Color fundus image, 1932 x 1916 pixels.
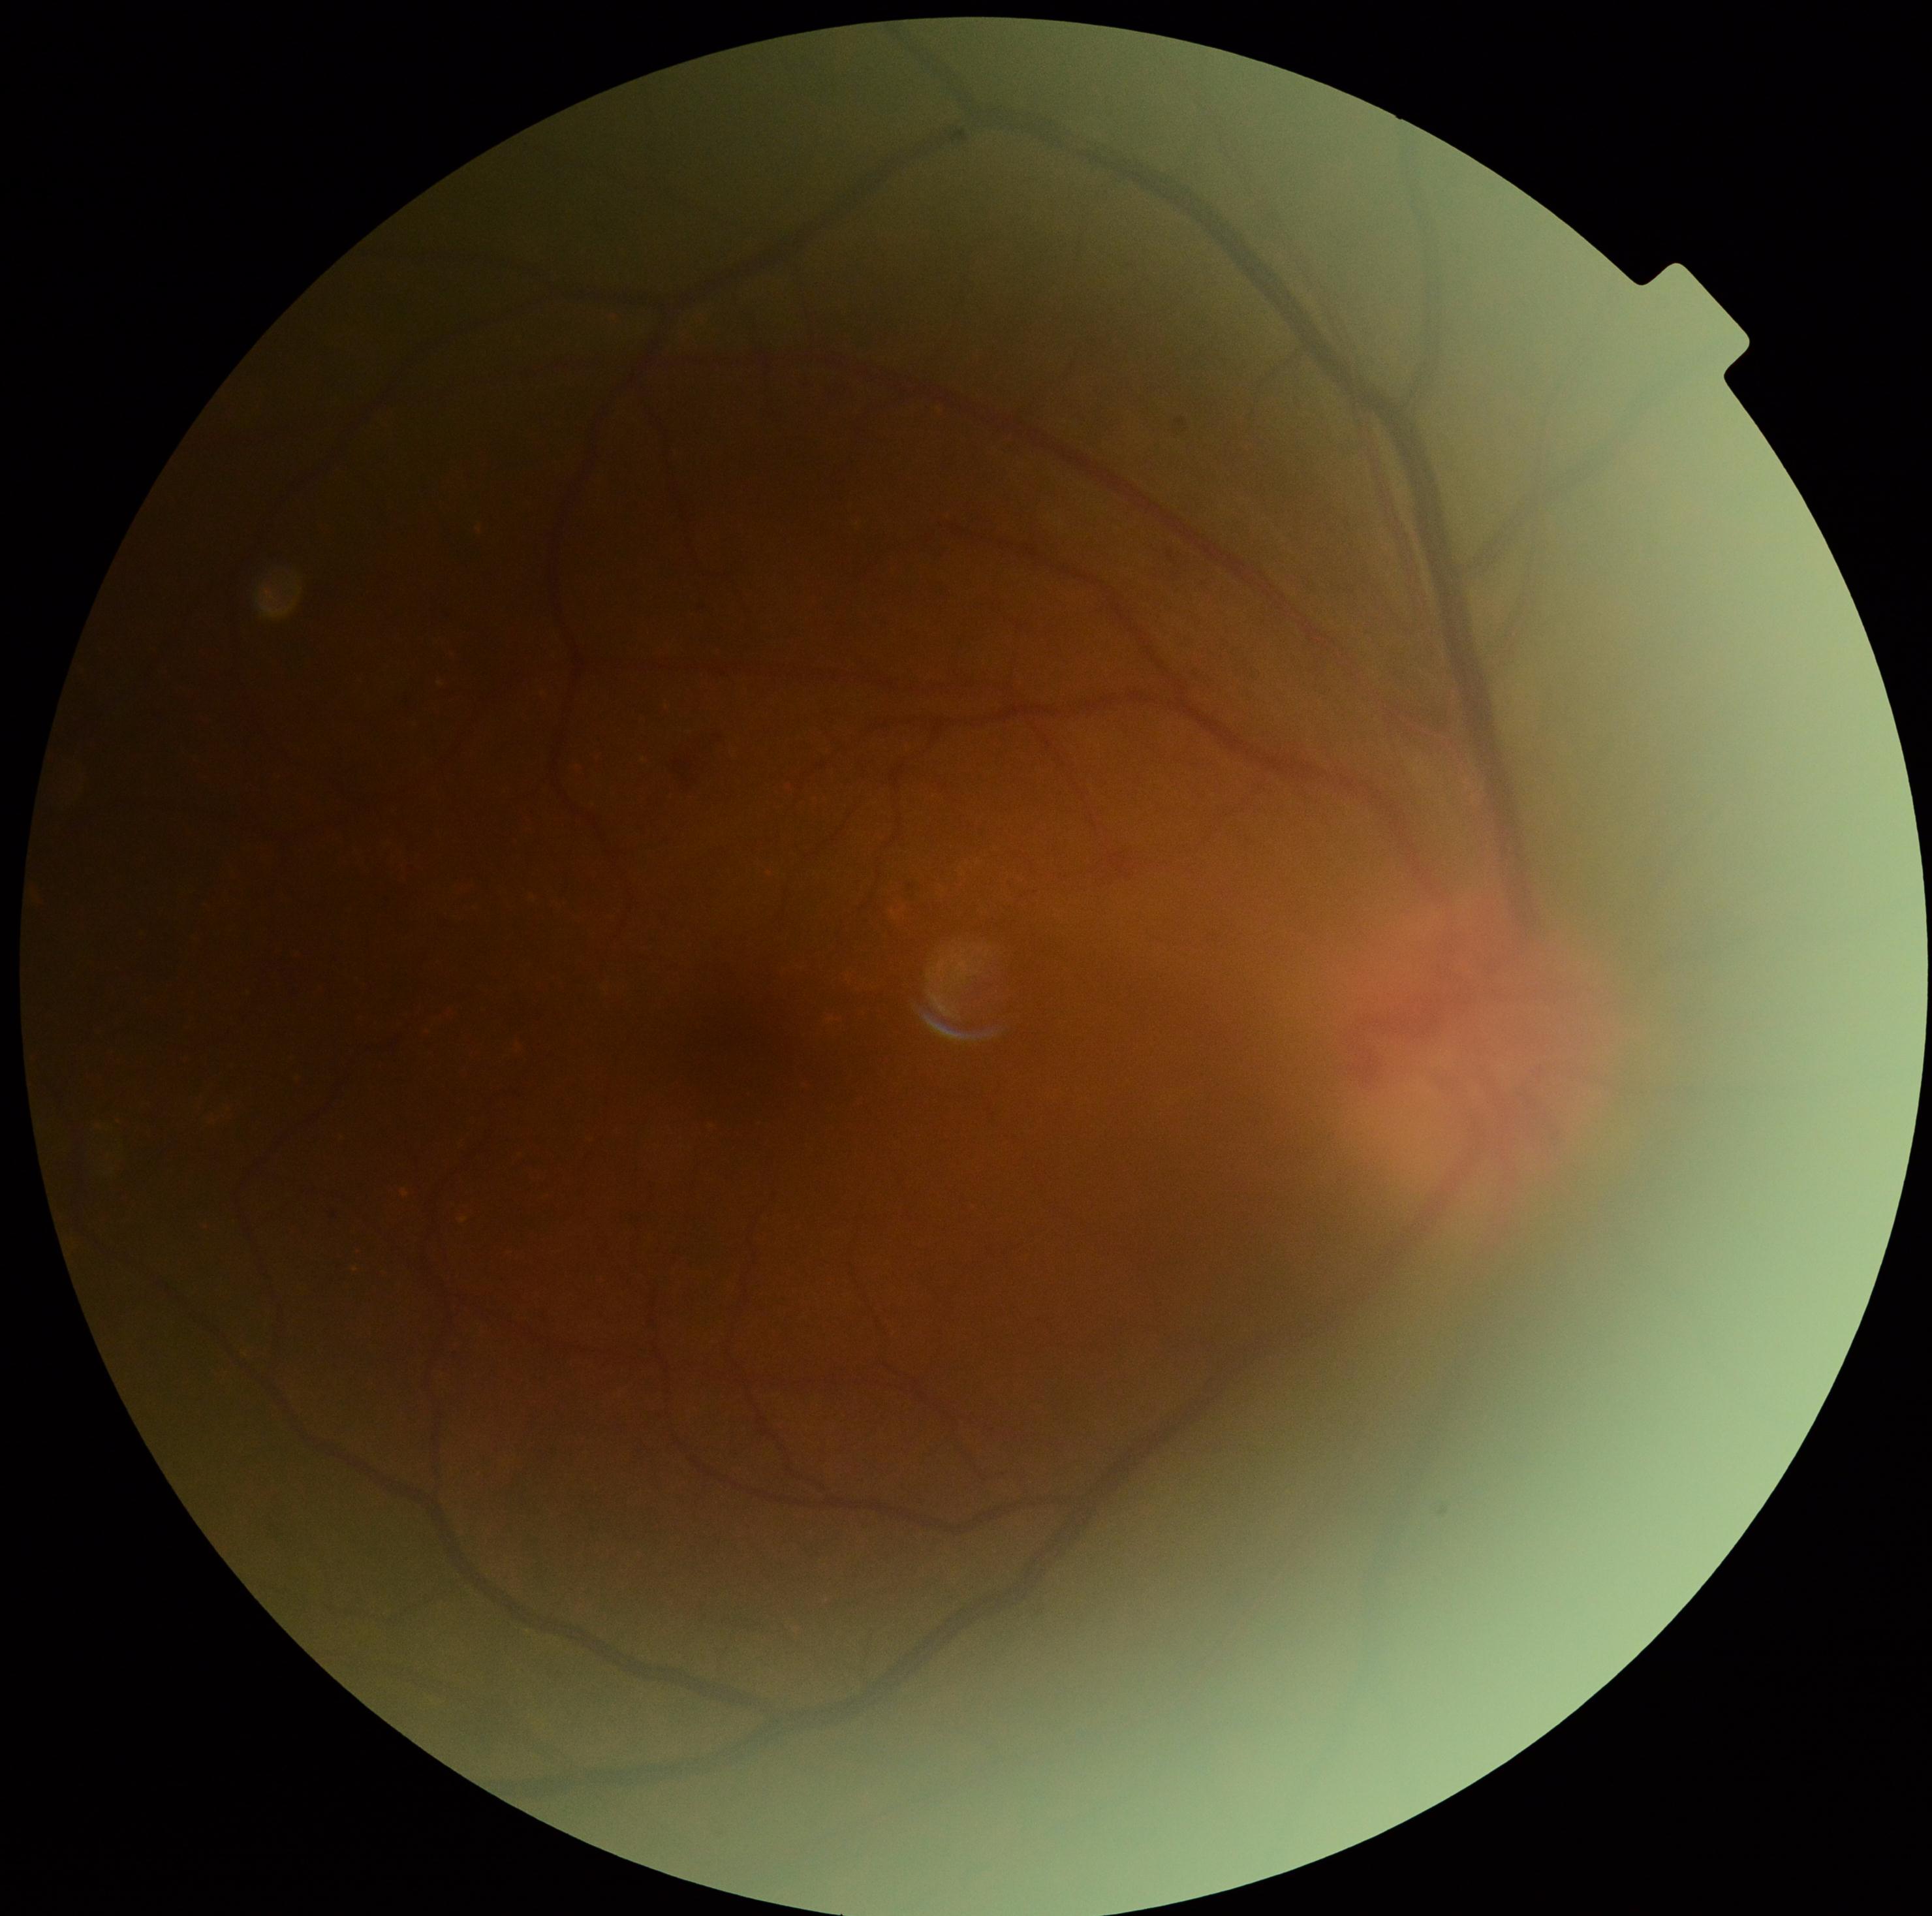 DR severity = moderate non-proliferative diabetic retinopathy (grade 2).